1444x1444px, FOV: 45 degrees, color fundus photograph
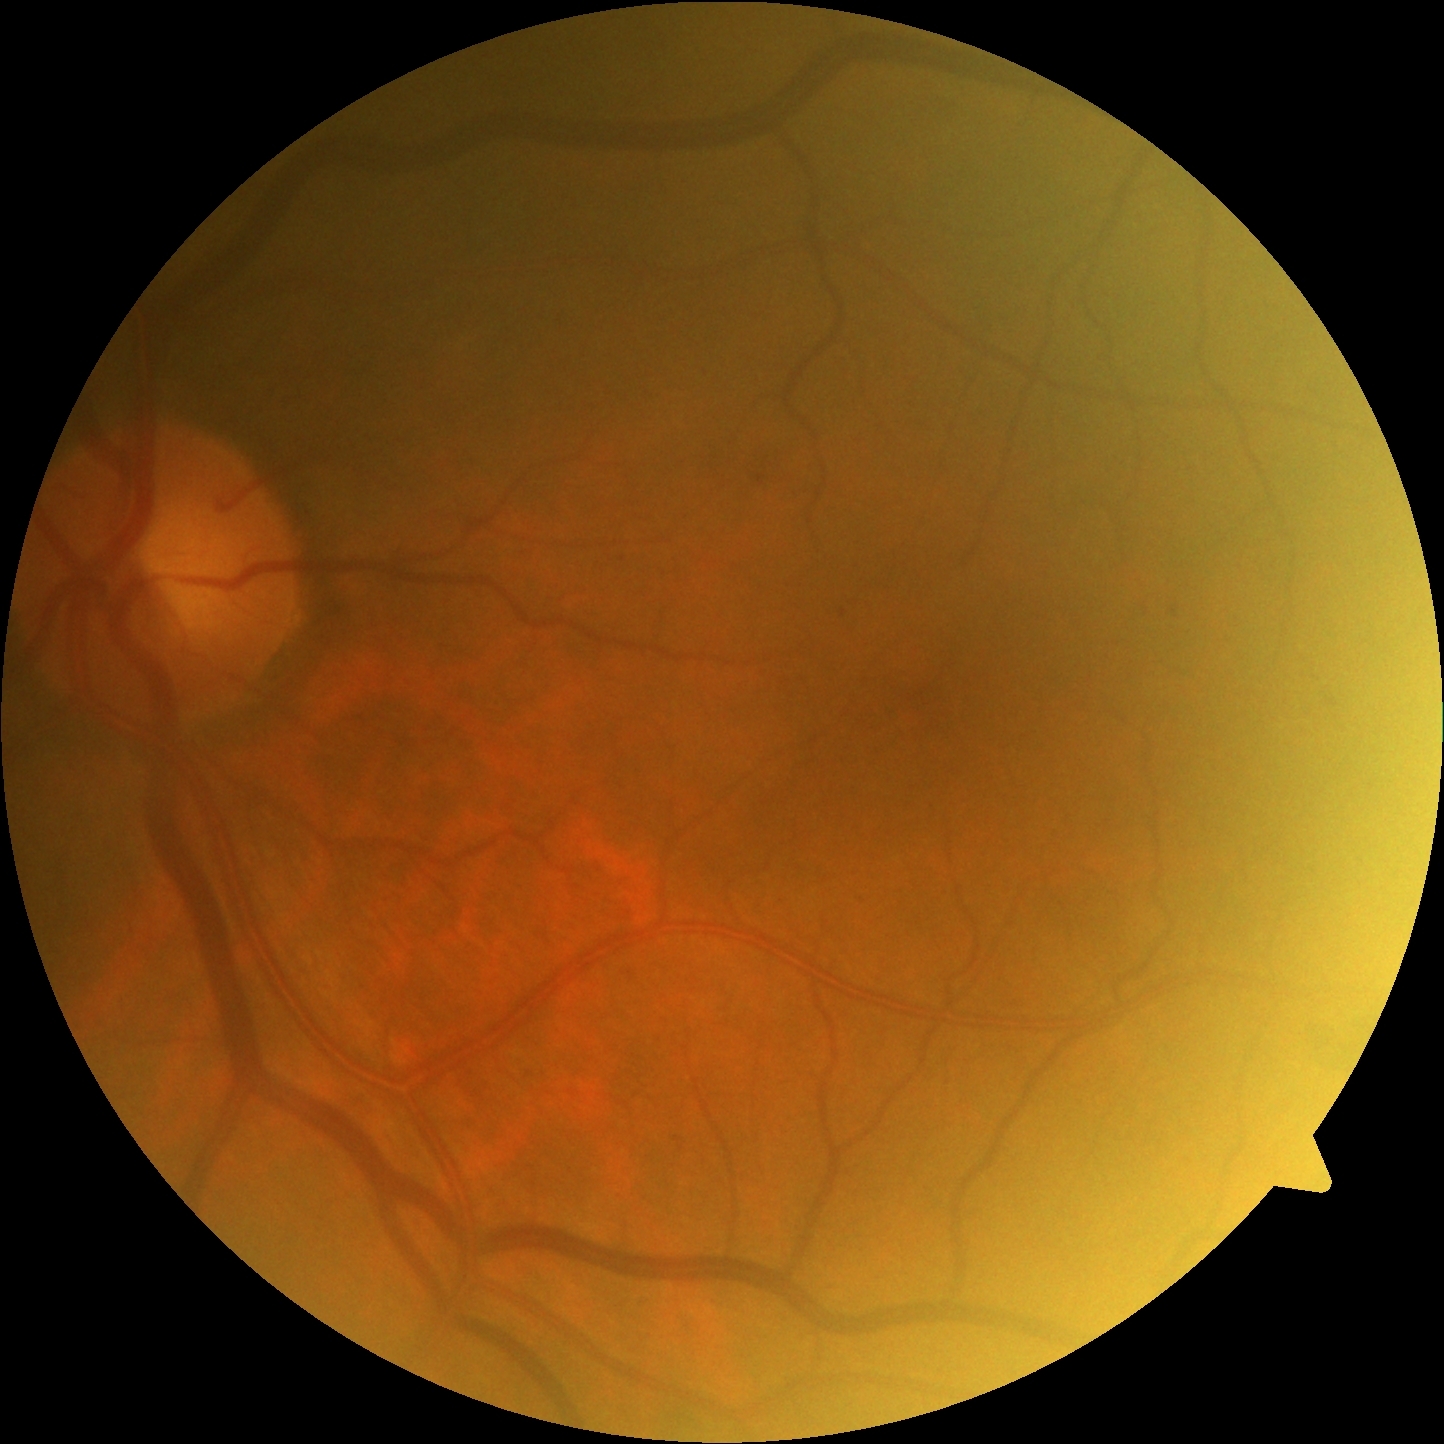 DR is mild non-proliferative diabetic retinopathy (grade 1).